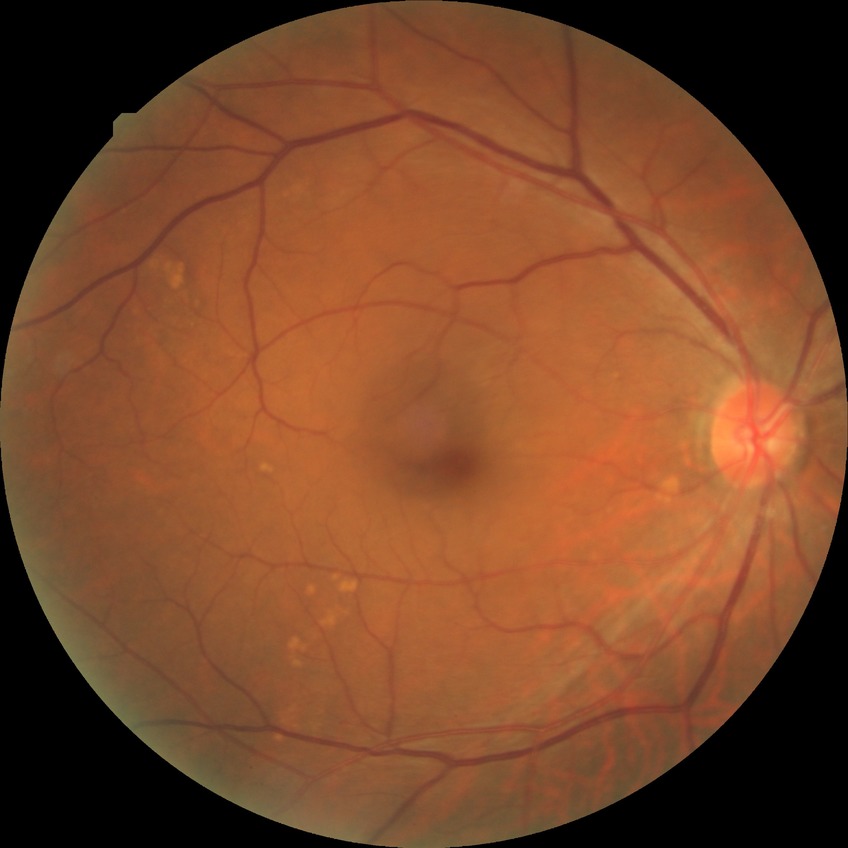

diabetic retinopathy (DR): NDR (no diabetic retinopathy)